Nonmydriatic · Davis DR grading: 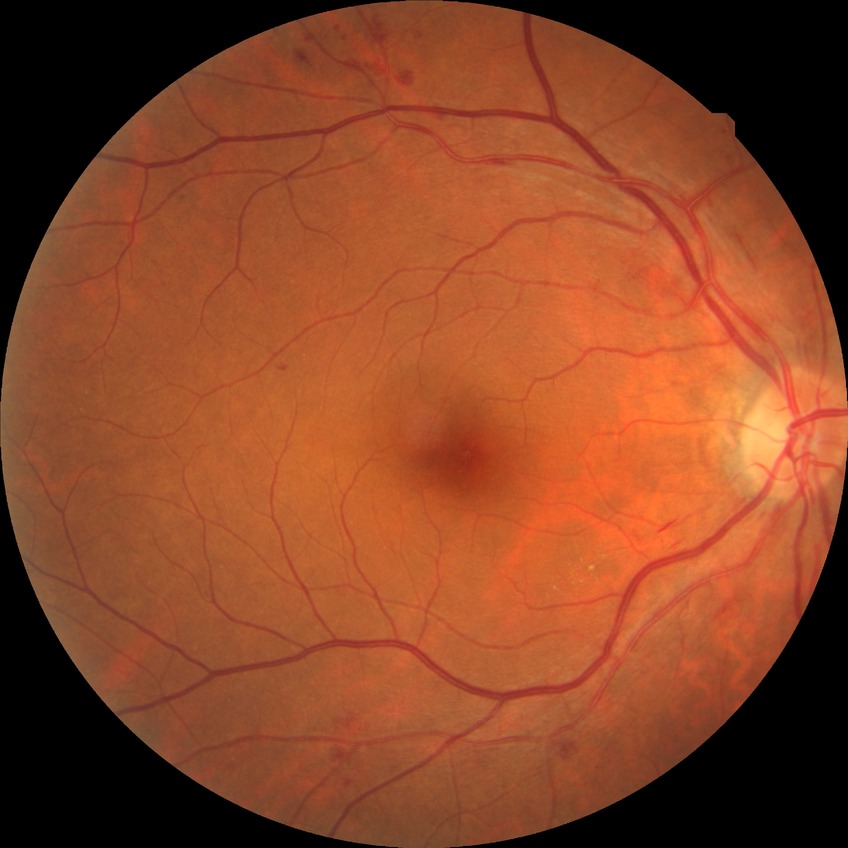 modified Davis grading@simple diabetic retinopathy.